Modified Davis classification; color fundus photograph; acquired with a NIDEK AFC-230
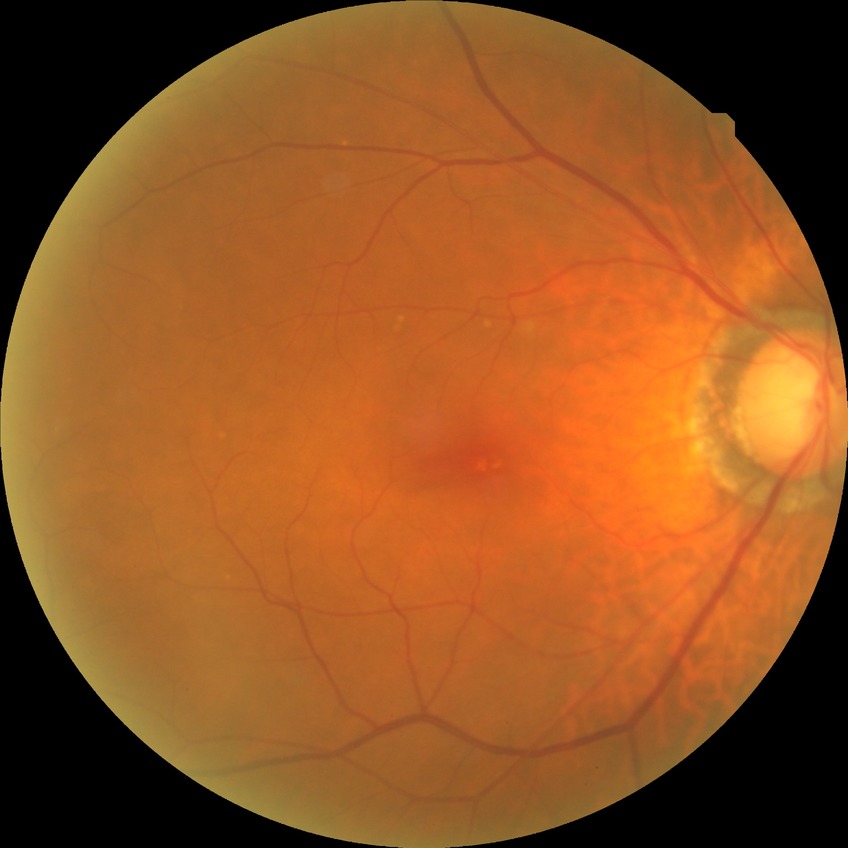

diabetic retinopathy (DR) = no diabetic retinopathy (NDR)